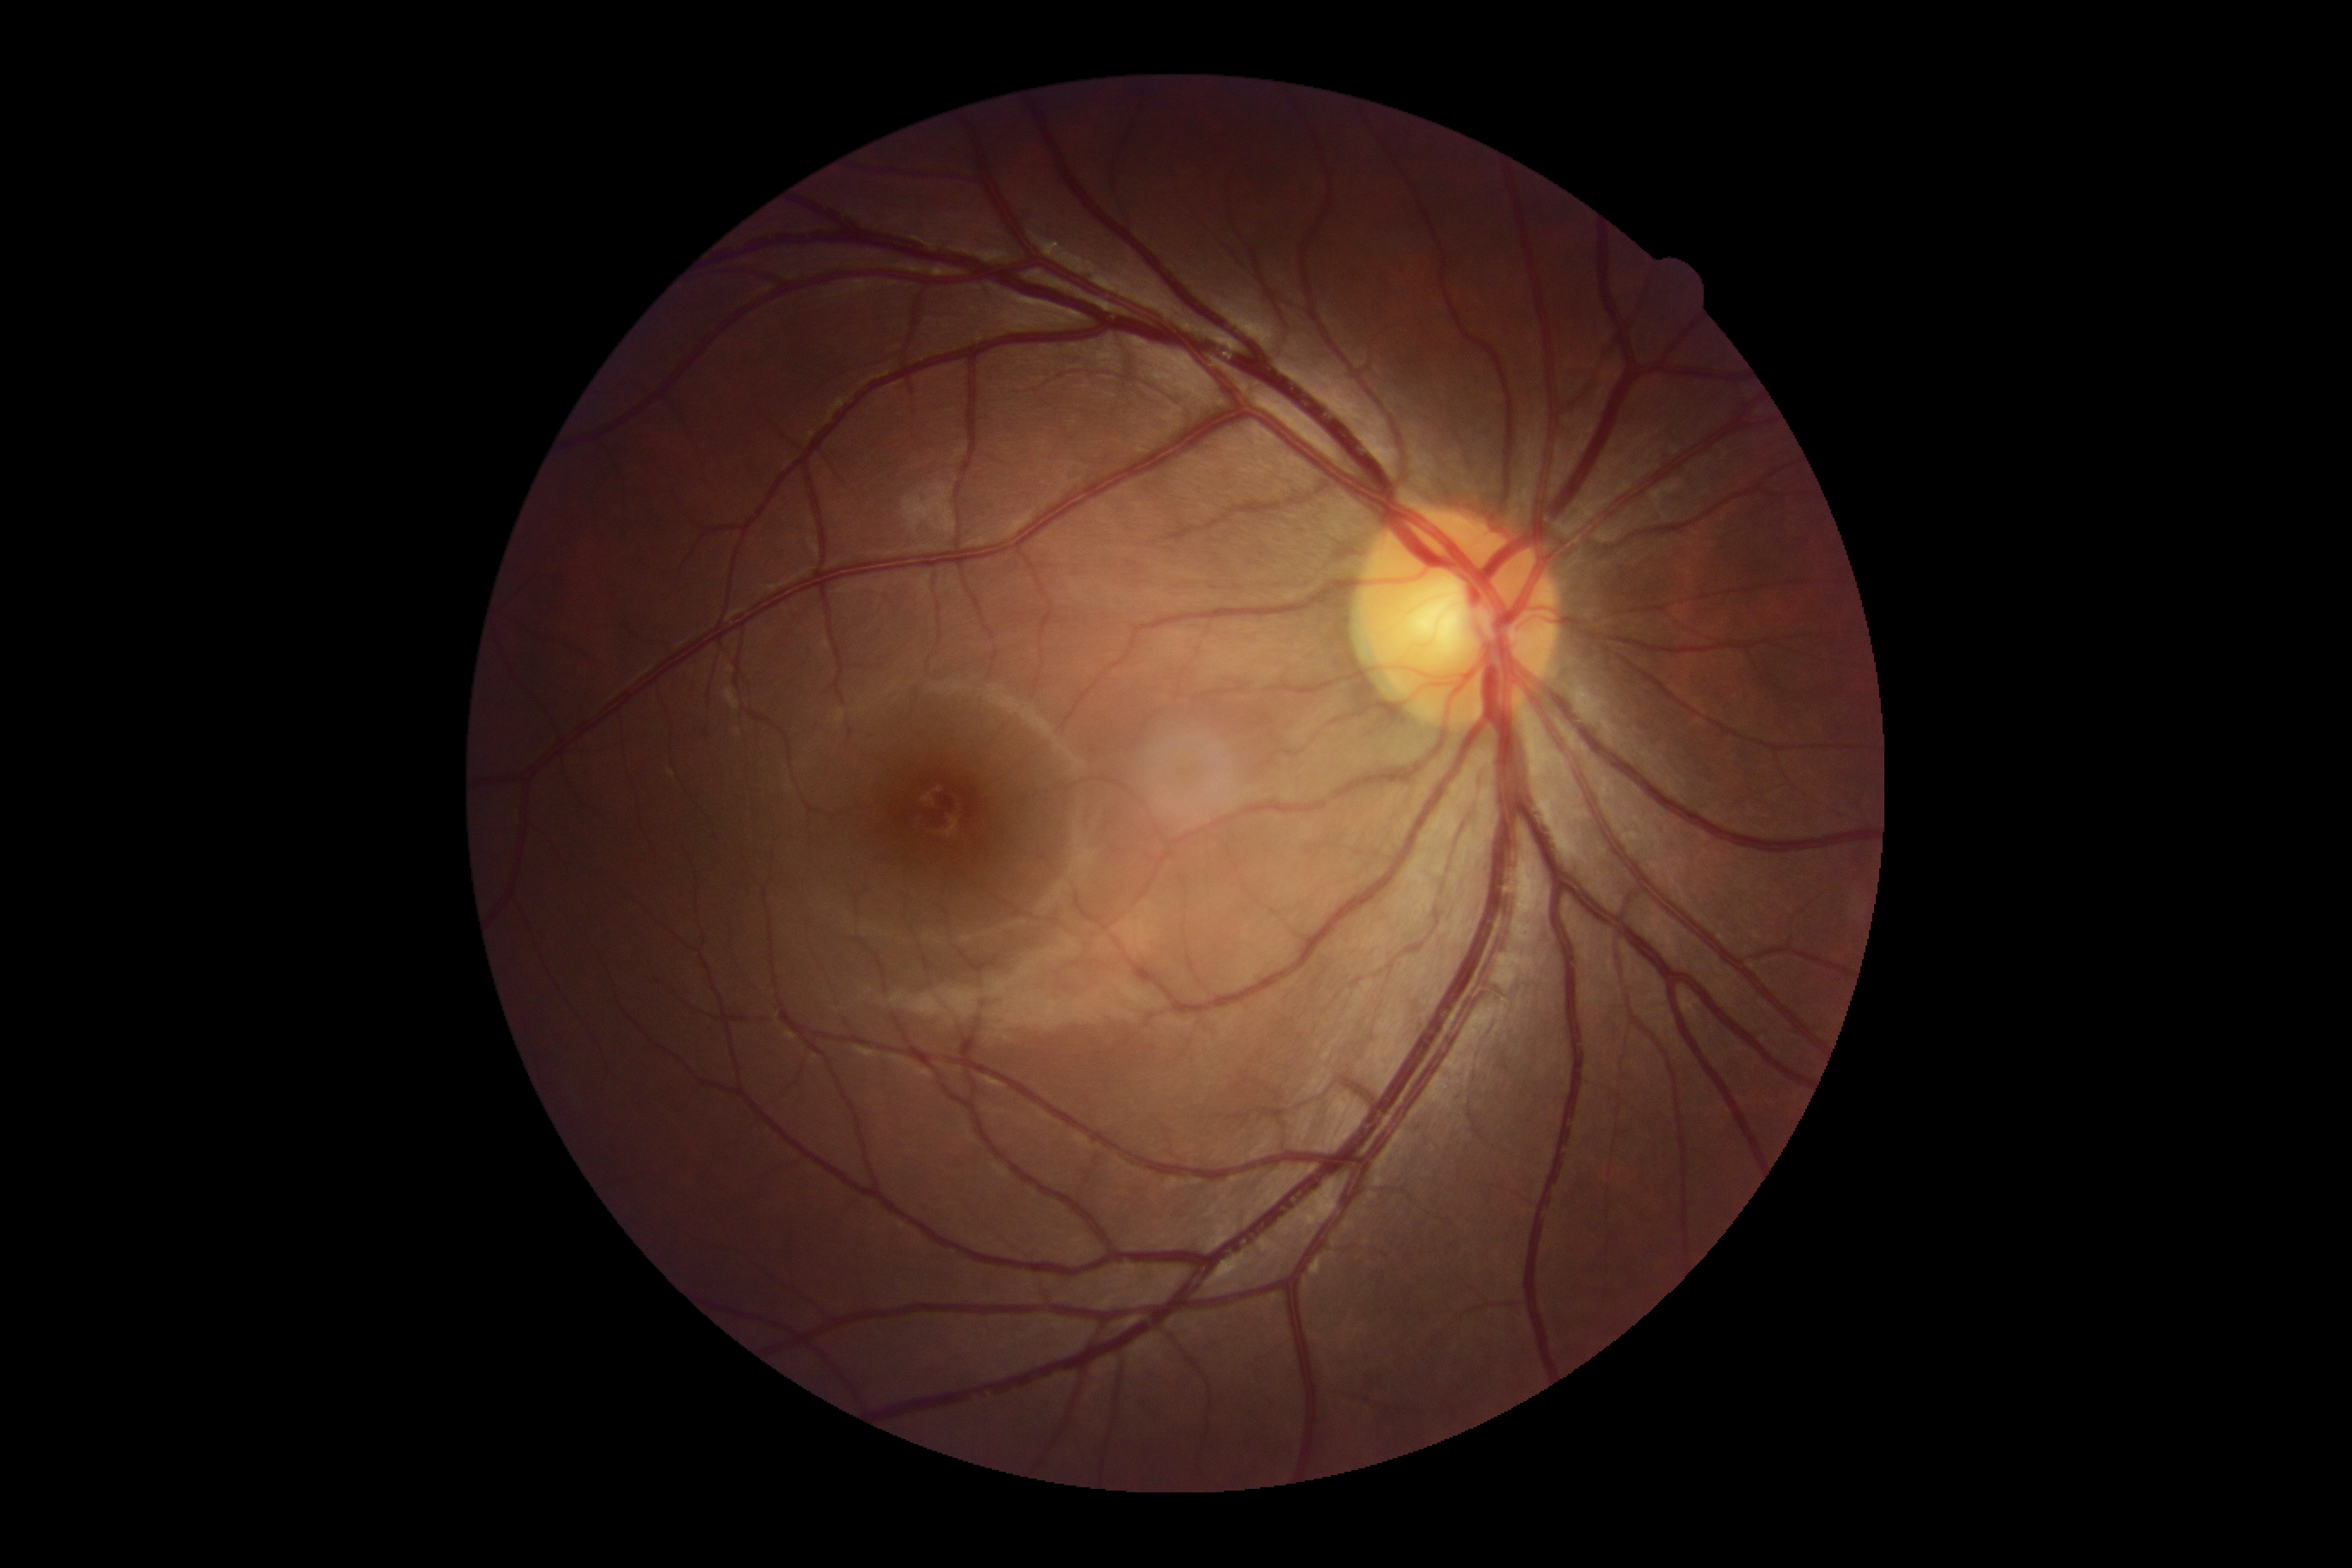 Retinopathy grade: 0.